RetCam wide-field infant fundus image. Captured with the Clarity RetCam 3 (130° field of view)
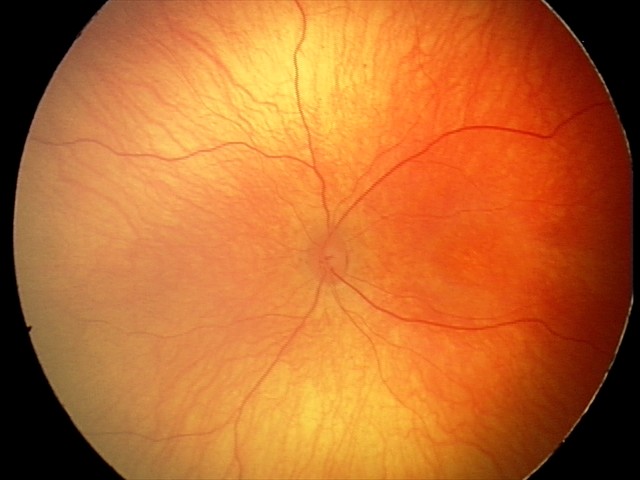 Physiological retinal appearance for postconceptual age.